45° FOV — 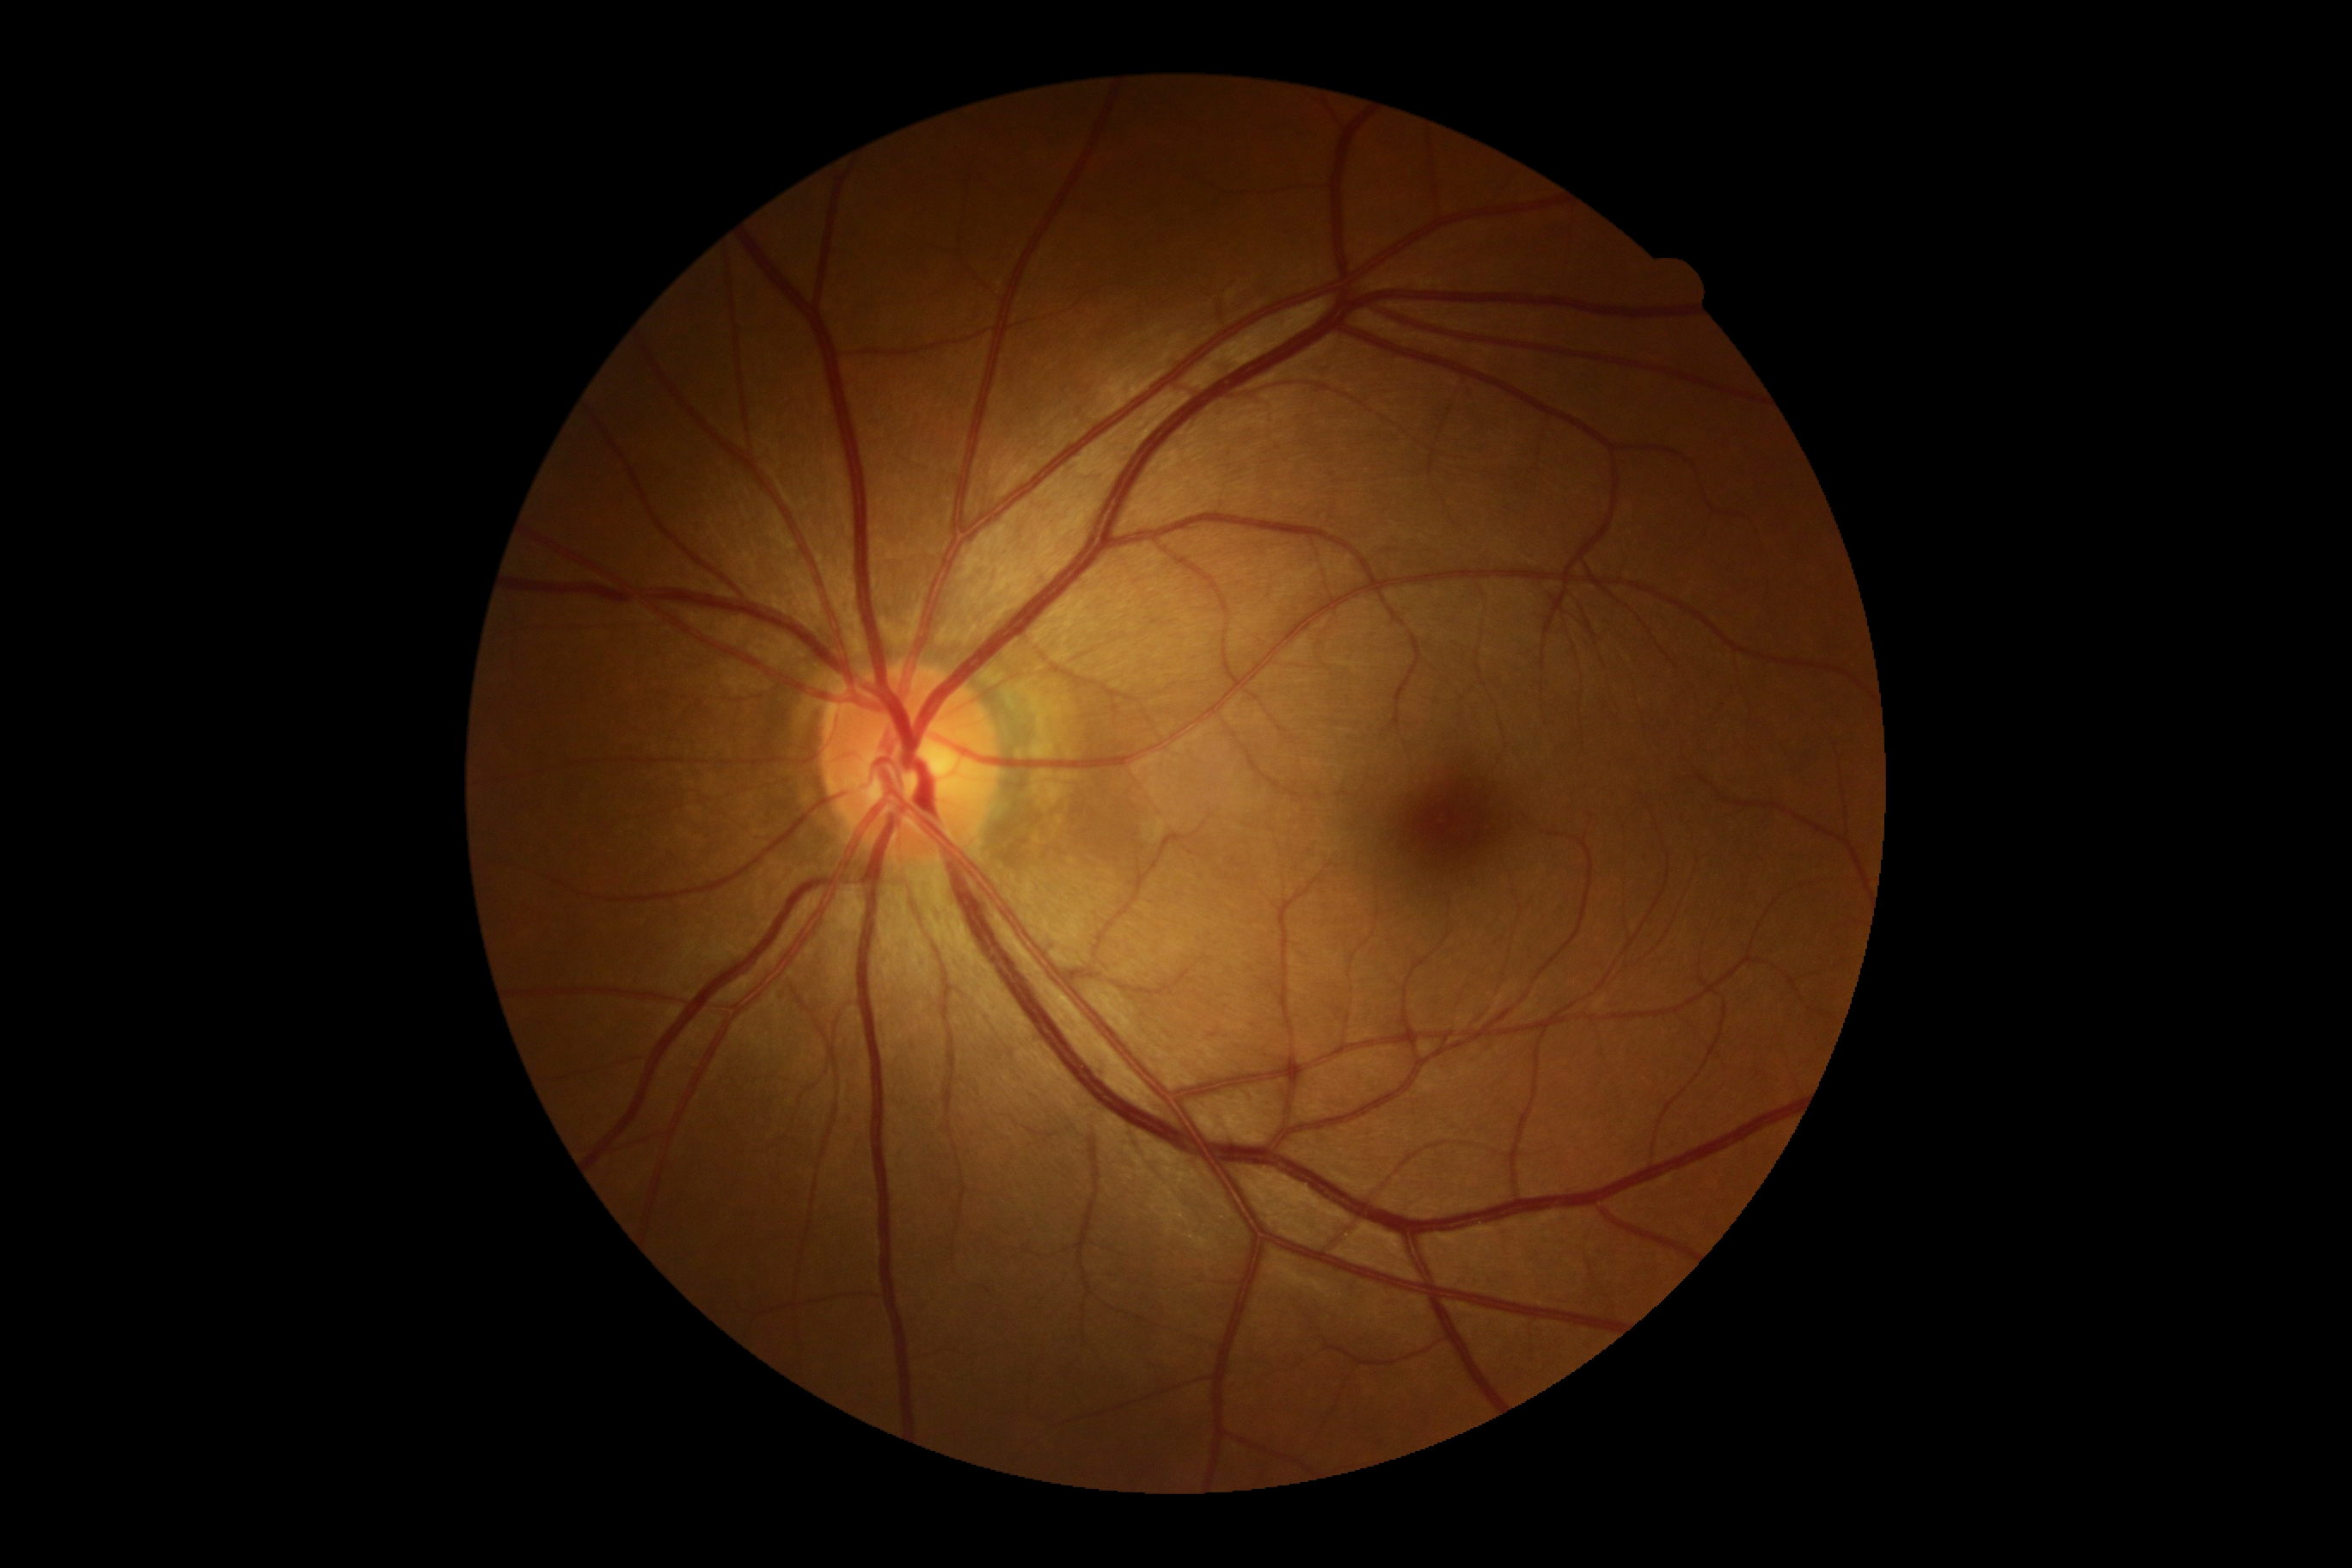 DR impression=no DR findings; diabetic retinopathy severity=no apparent retinopathy (grade 0).